1240 x 1240 pixels. Phoenix ICON wide-field infant fundus image
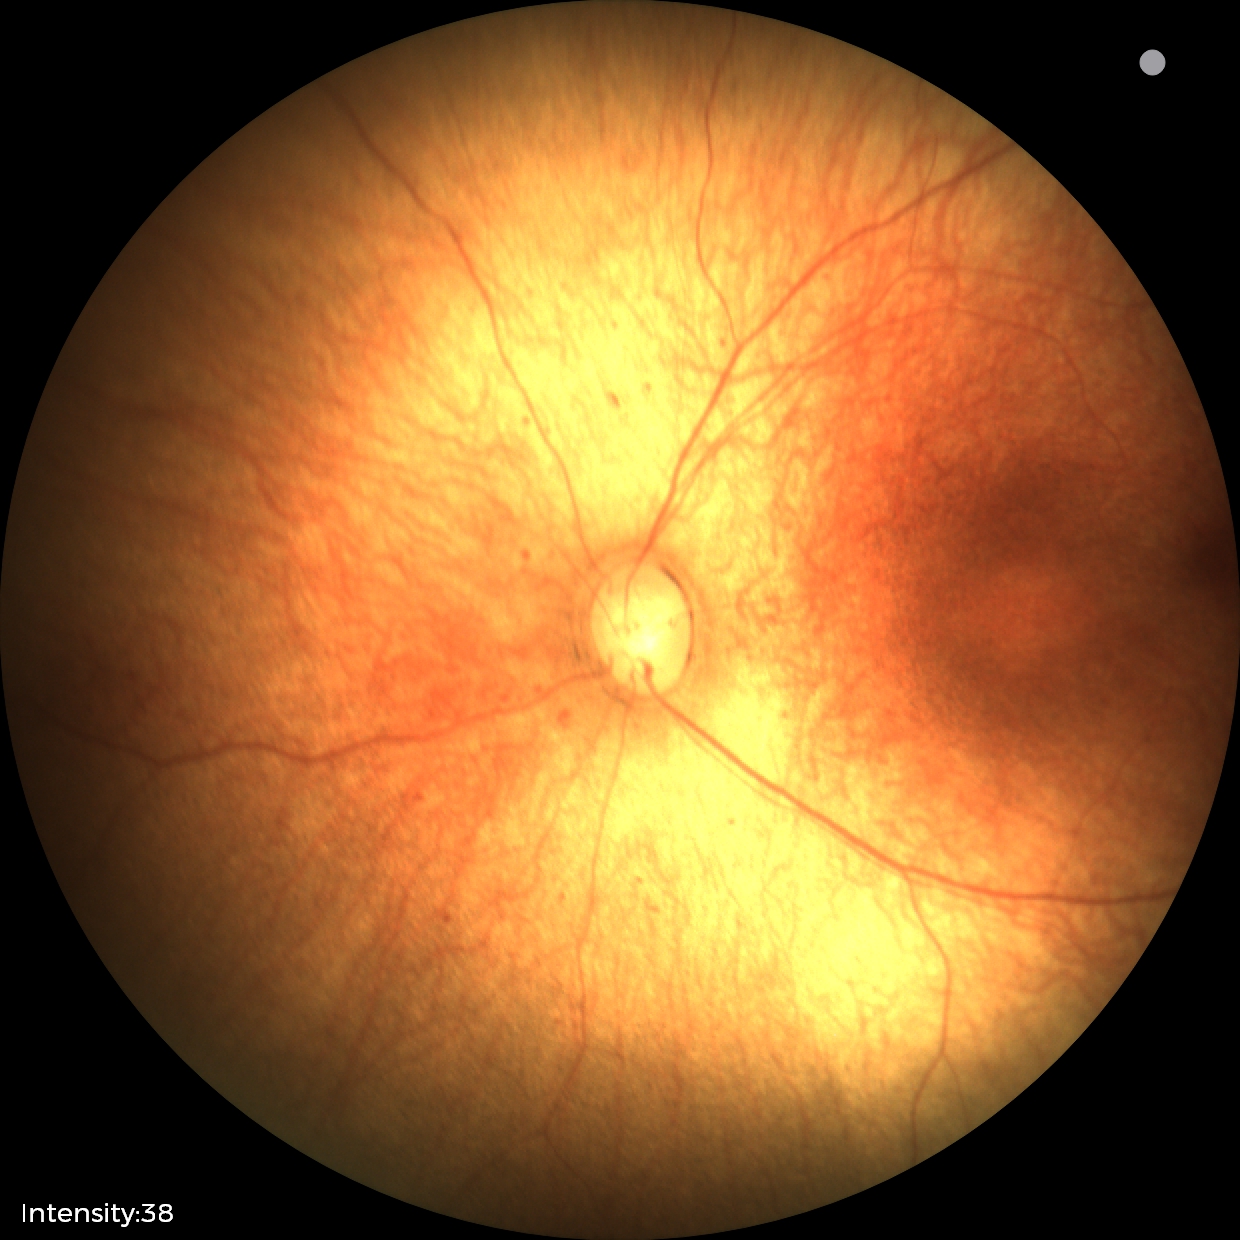
Physiological retinal appearance for postconceptual age.